NIDEK AFC-230 fundus camera. Nonmydriatic fundus photograph — 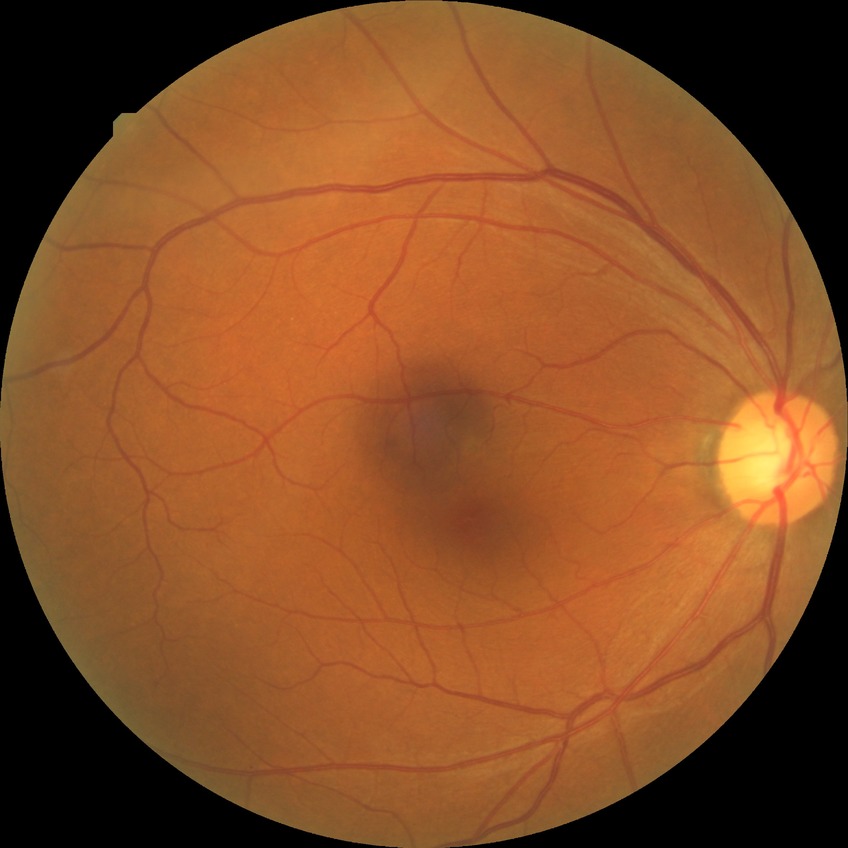 DR grade: NDR. No signs of diabetic retinopathy.